Acquired with a Nidek AFC-330:
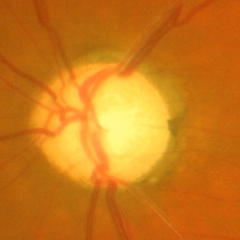
Glaucoma assessment = advanced glaucoma.